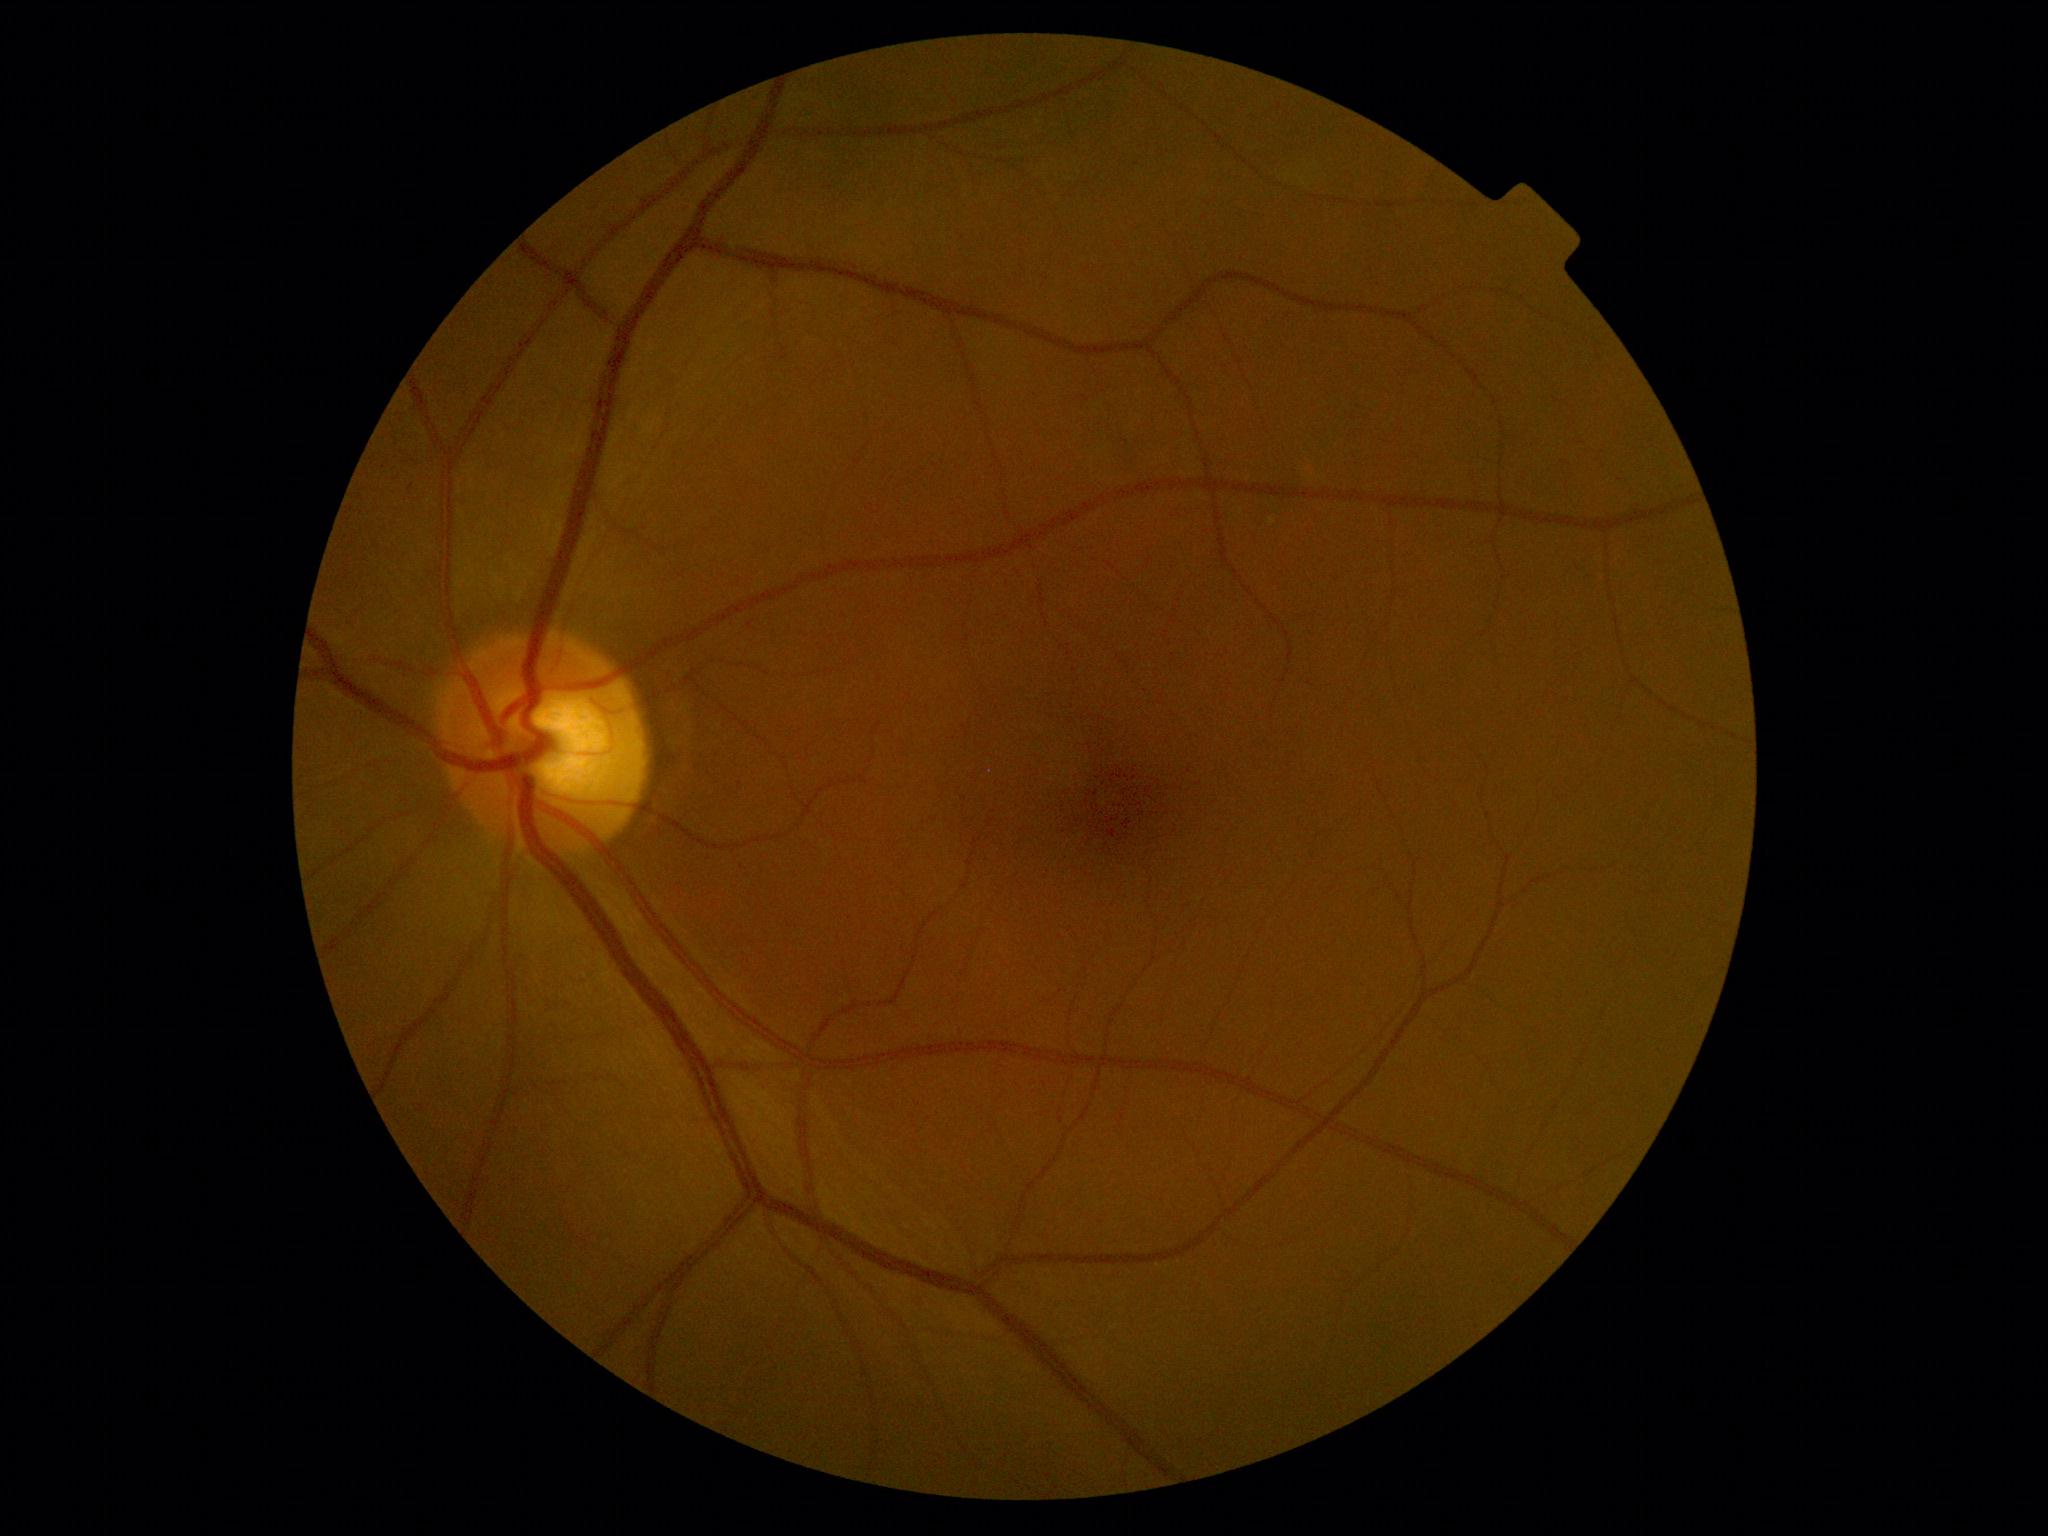
Annotations:
– DR severity — grade 0 (no apparent retinopathy)